2212x1661. CFP. Captured without pupil dilation. 30-degree field of view. Acquired with a Topcon TRC-NW400. Optic disc at the center of the field. Axial length 23.95 mm.
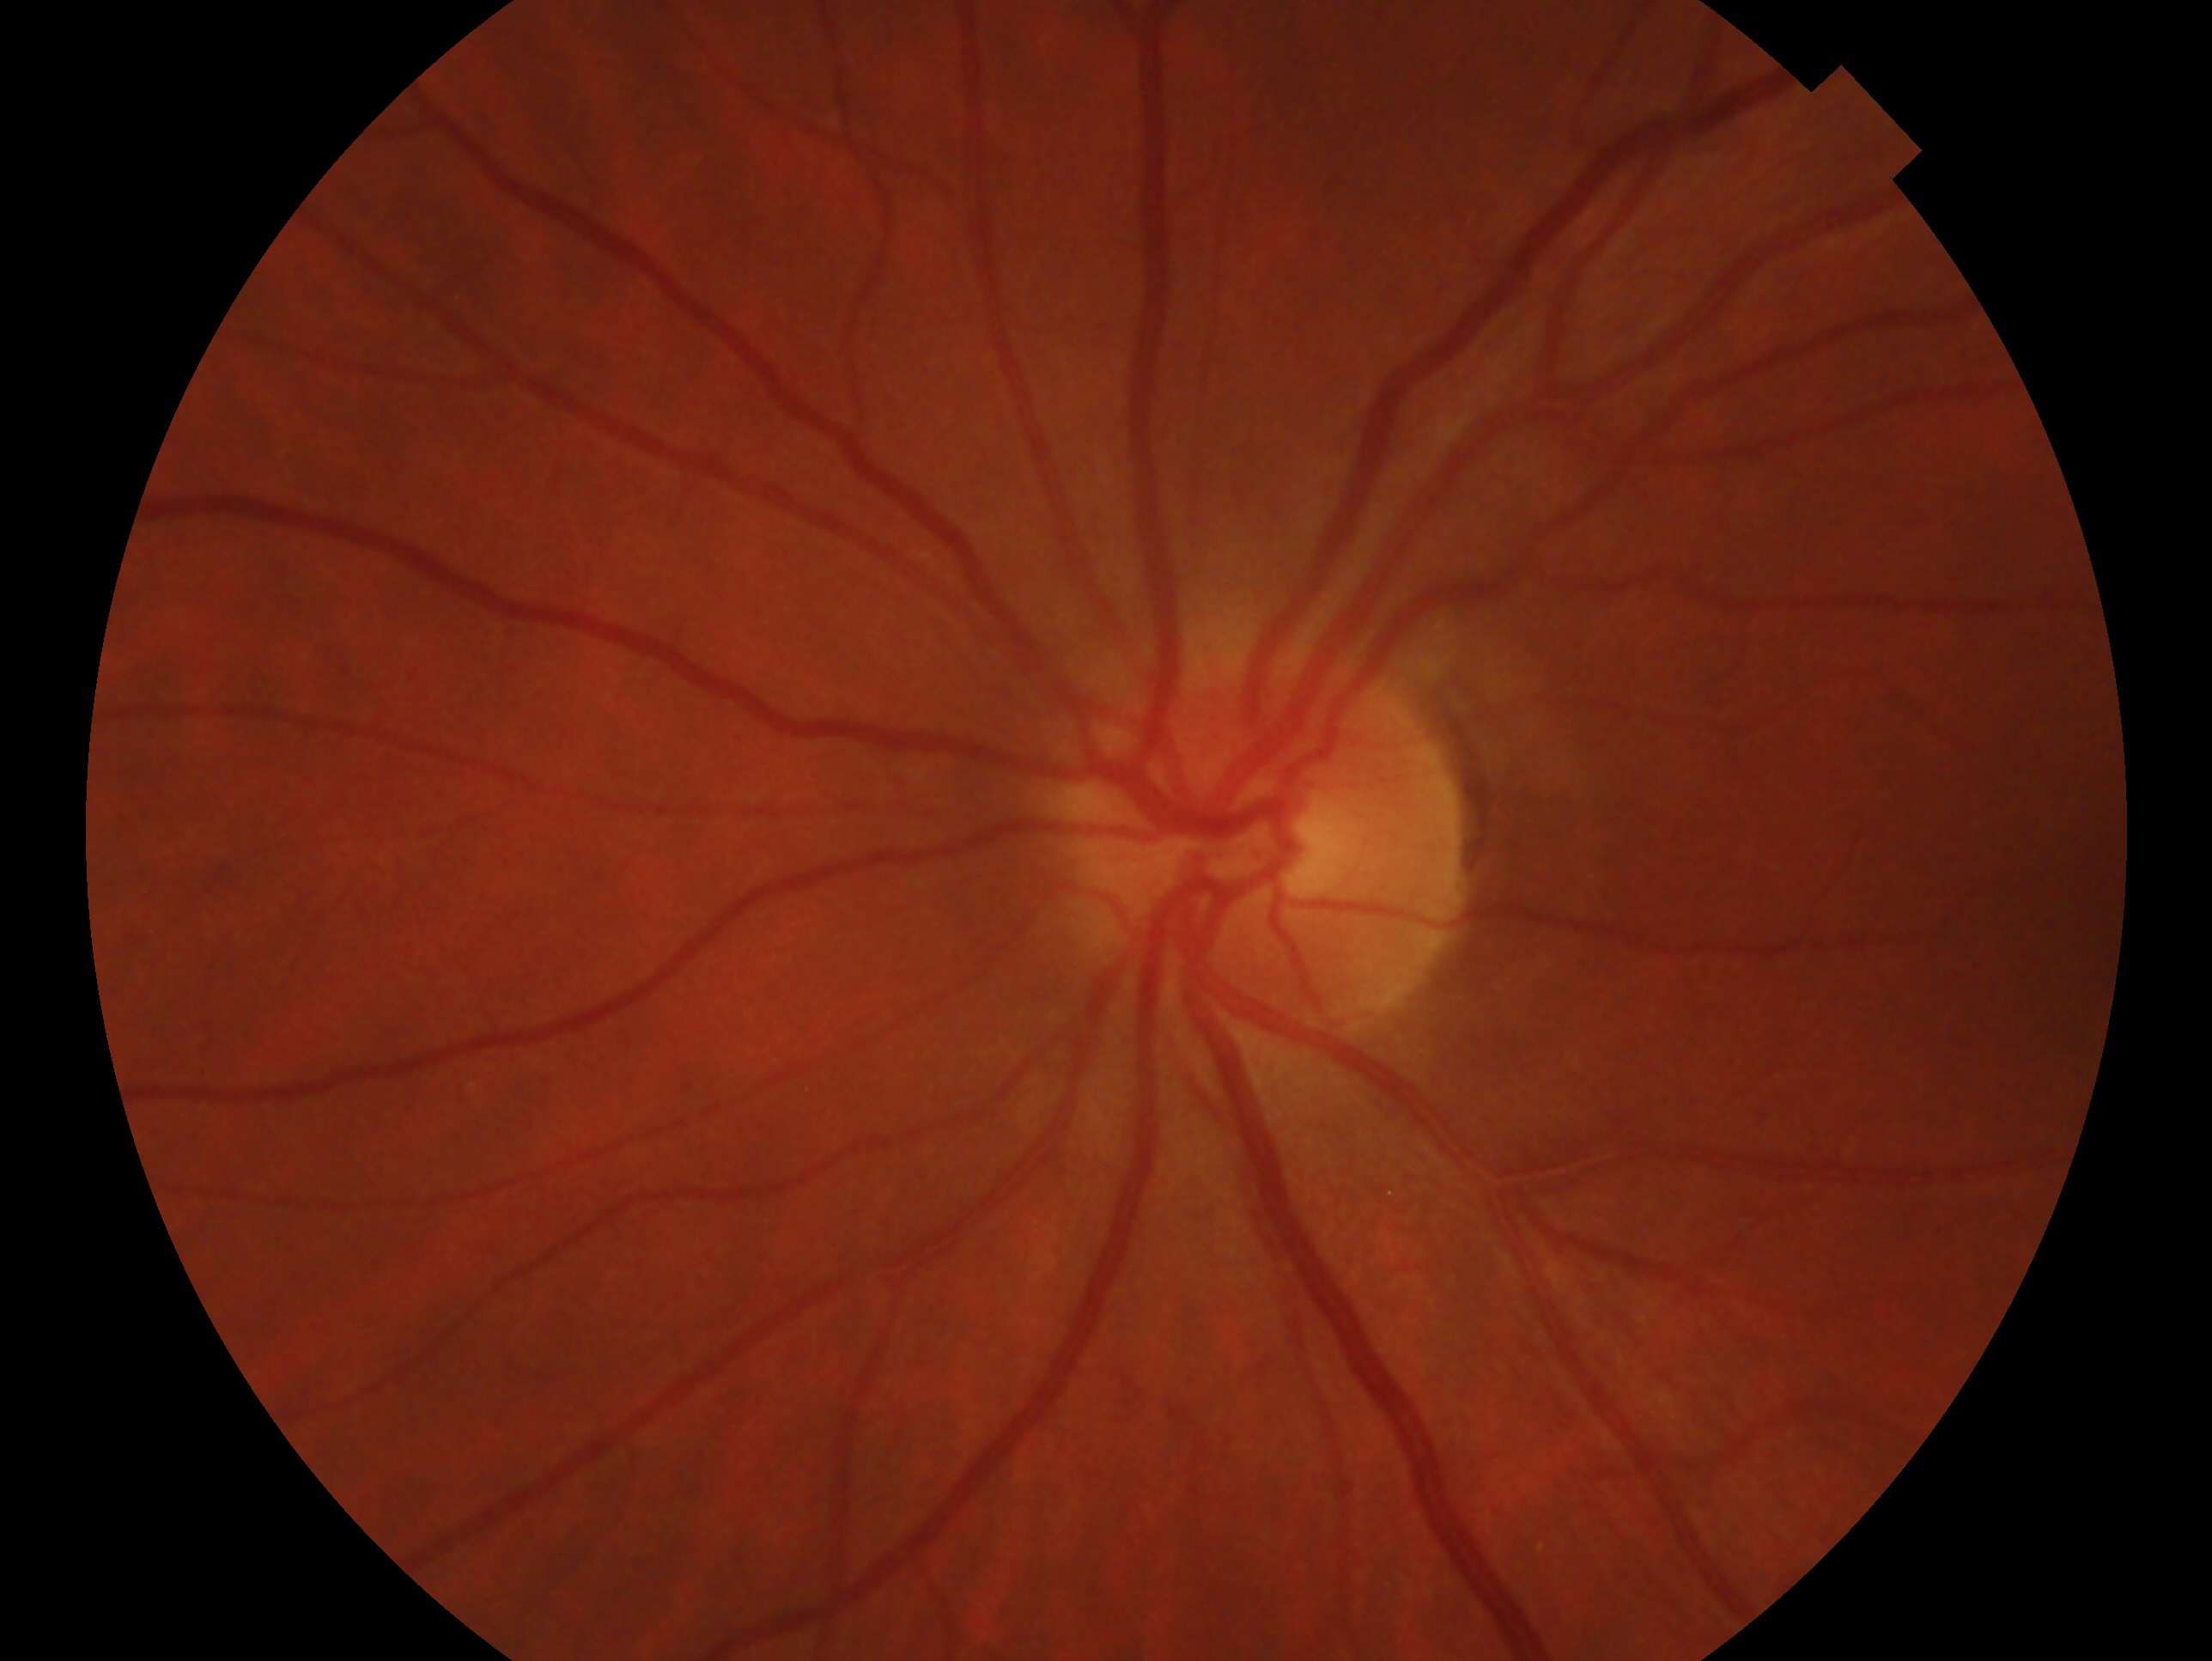 Imaged eye: left.
Glaucoma status — no glaucomatous findings.